Wide-field fundus image from infant ROP screening. 640 x 480 pixels. 130° field of view (Clarity RetCam 3): 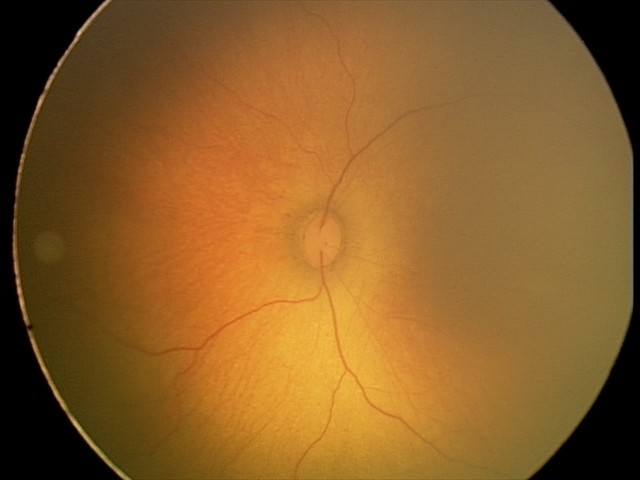

Screening: physiological finding.